Fundus photo. Camera: NIDEK AFC-230
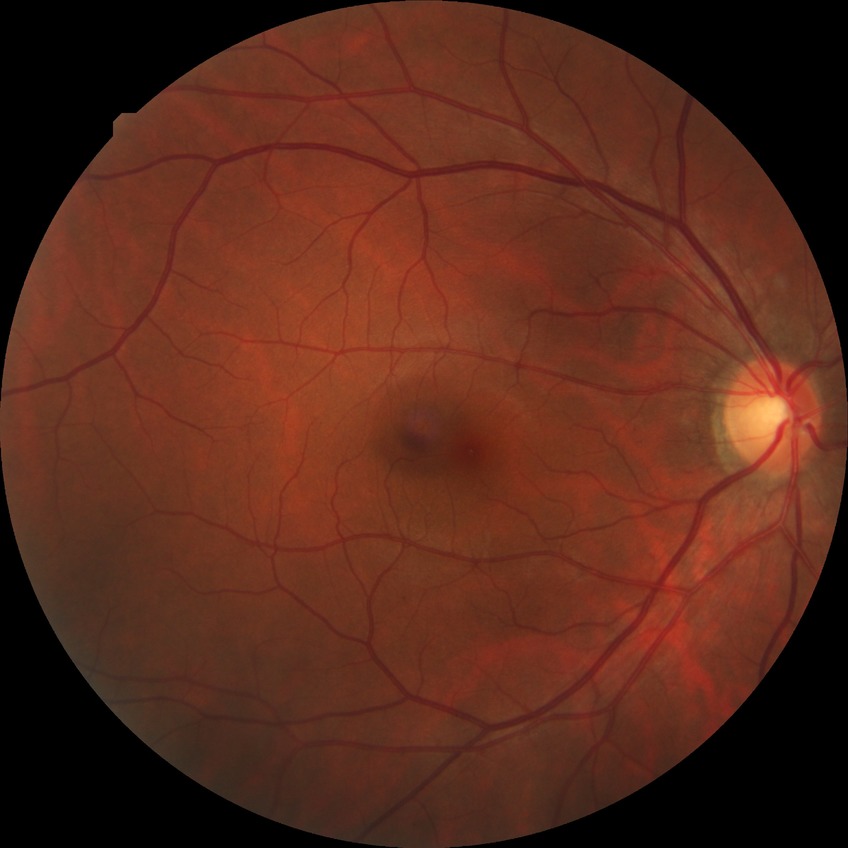
Diabetic retinopathy (DR): no diabetic retinopathy (NDR).